2352x1568px · retinal fundus photograph: 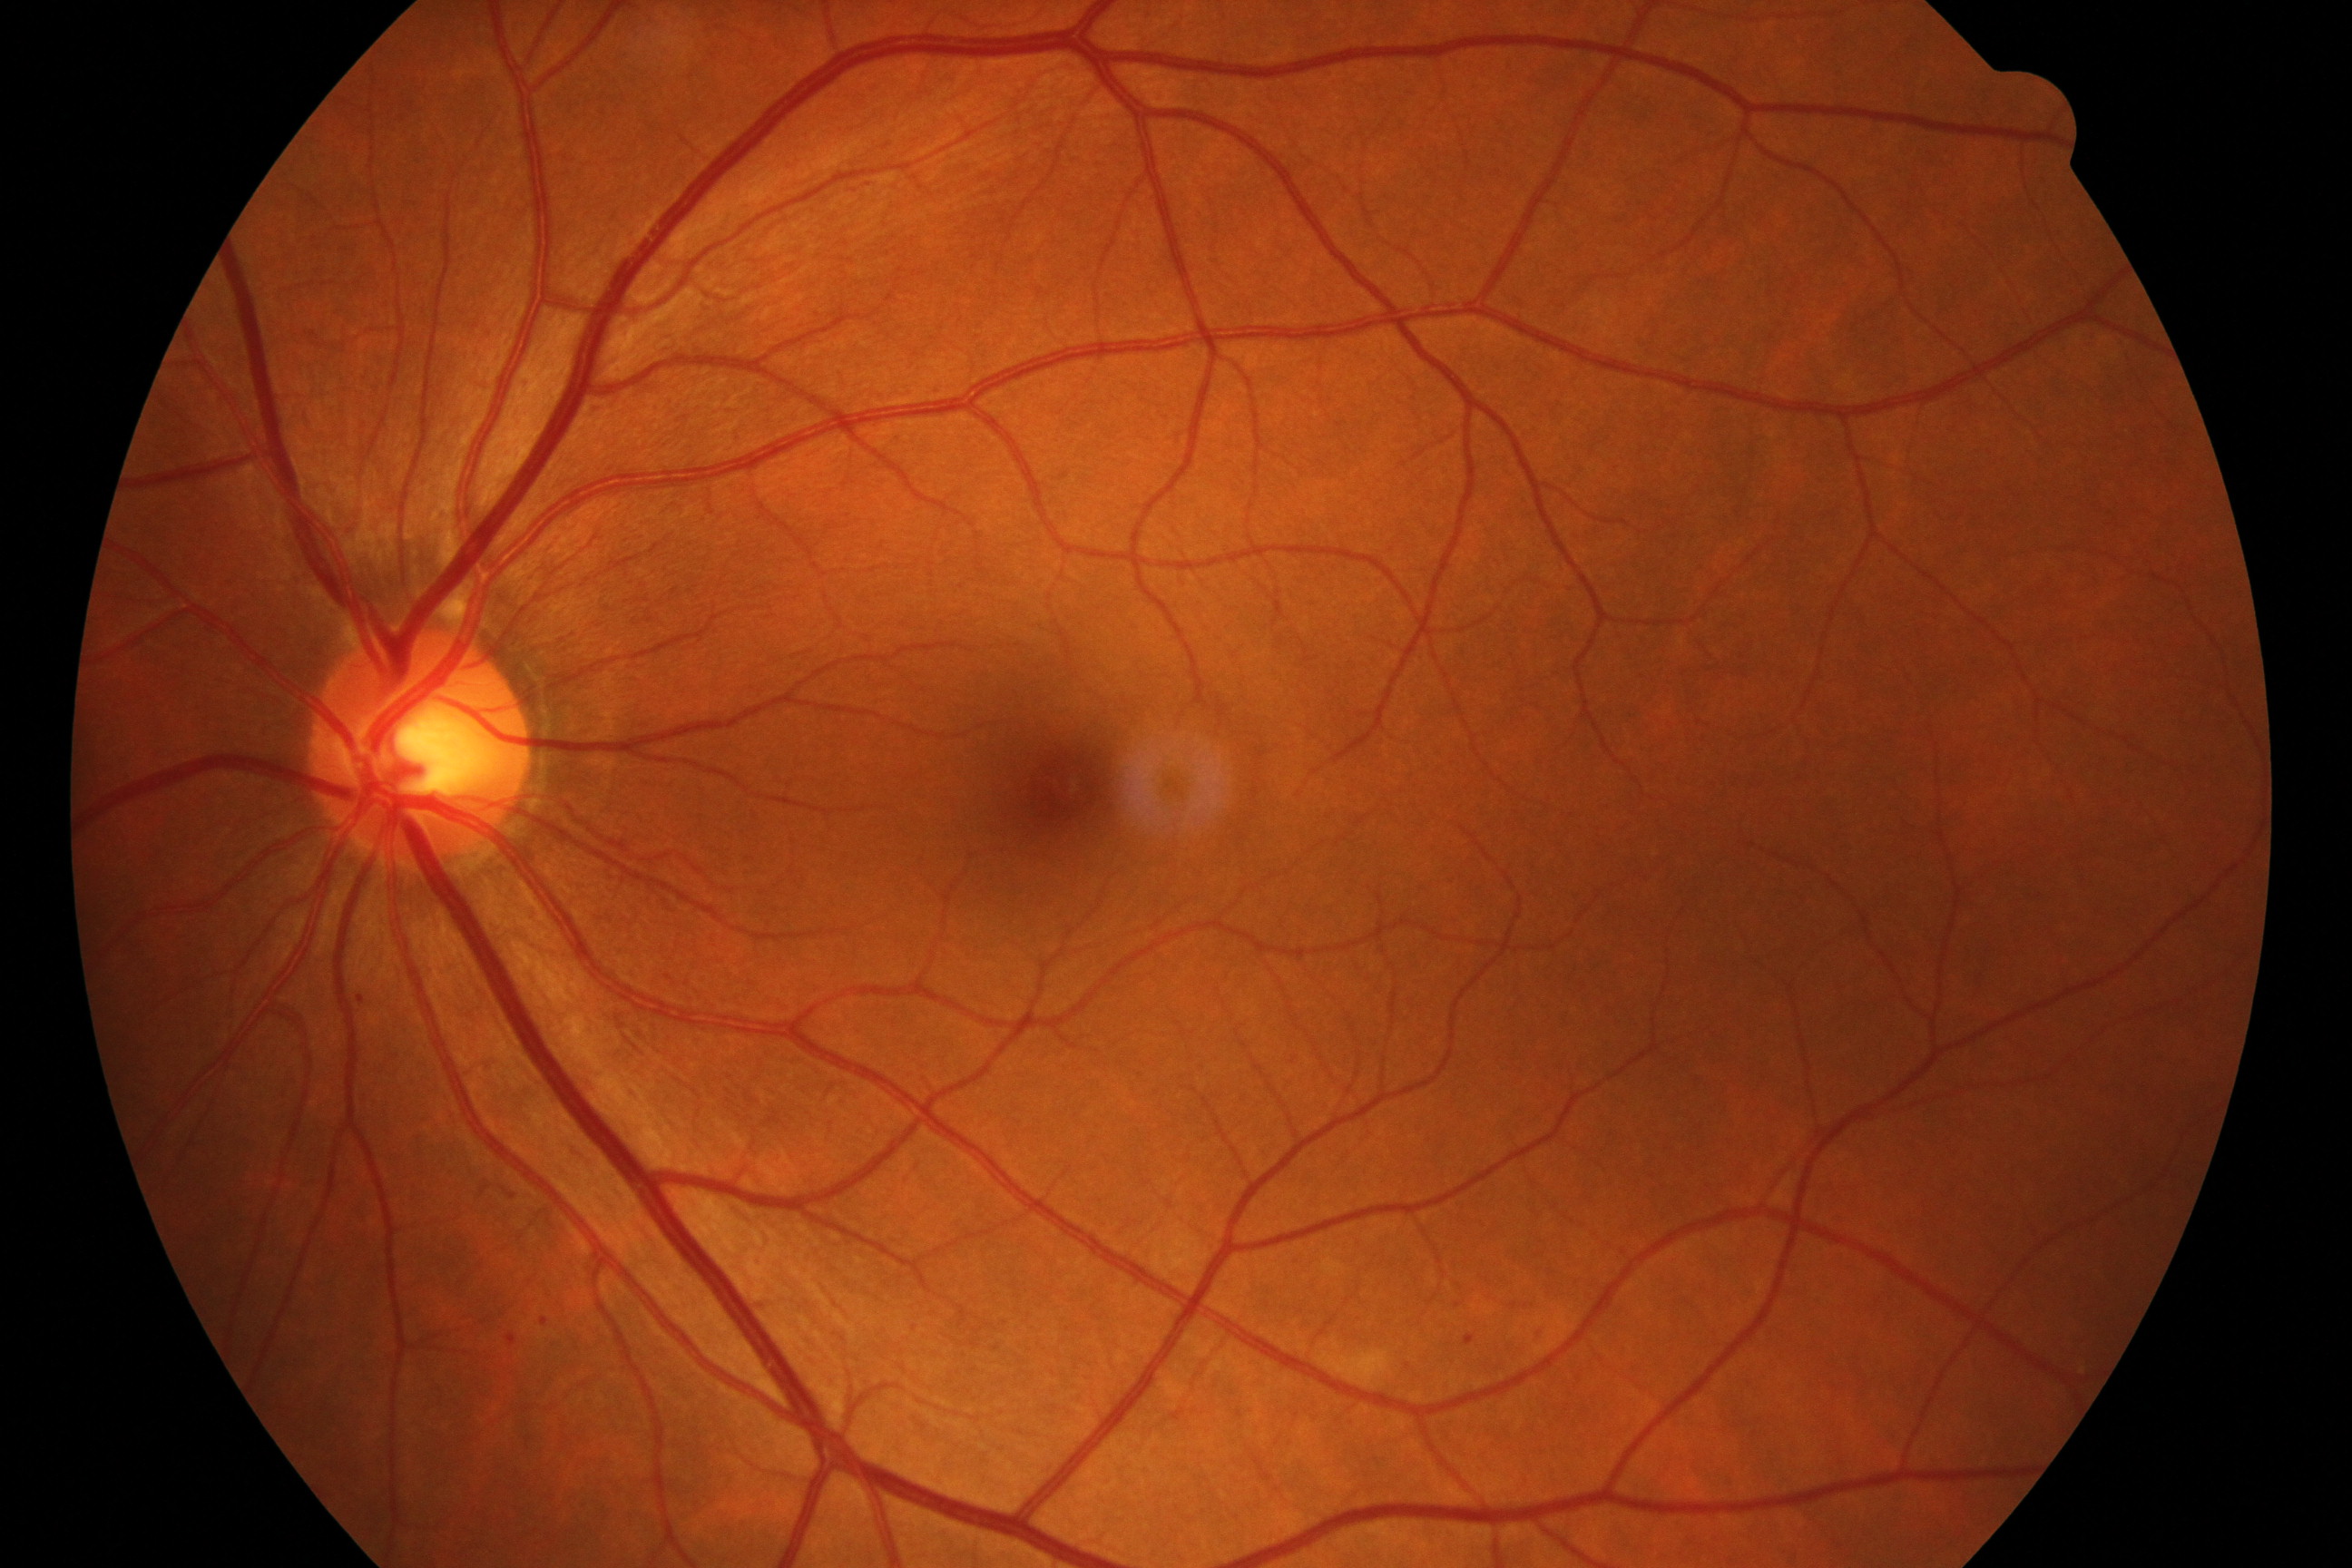

Classification: mild non-proliferative diabetic retinopathy.